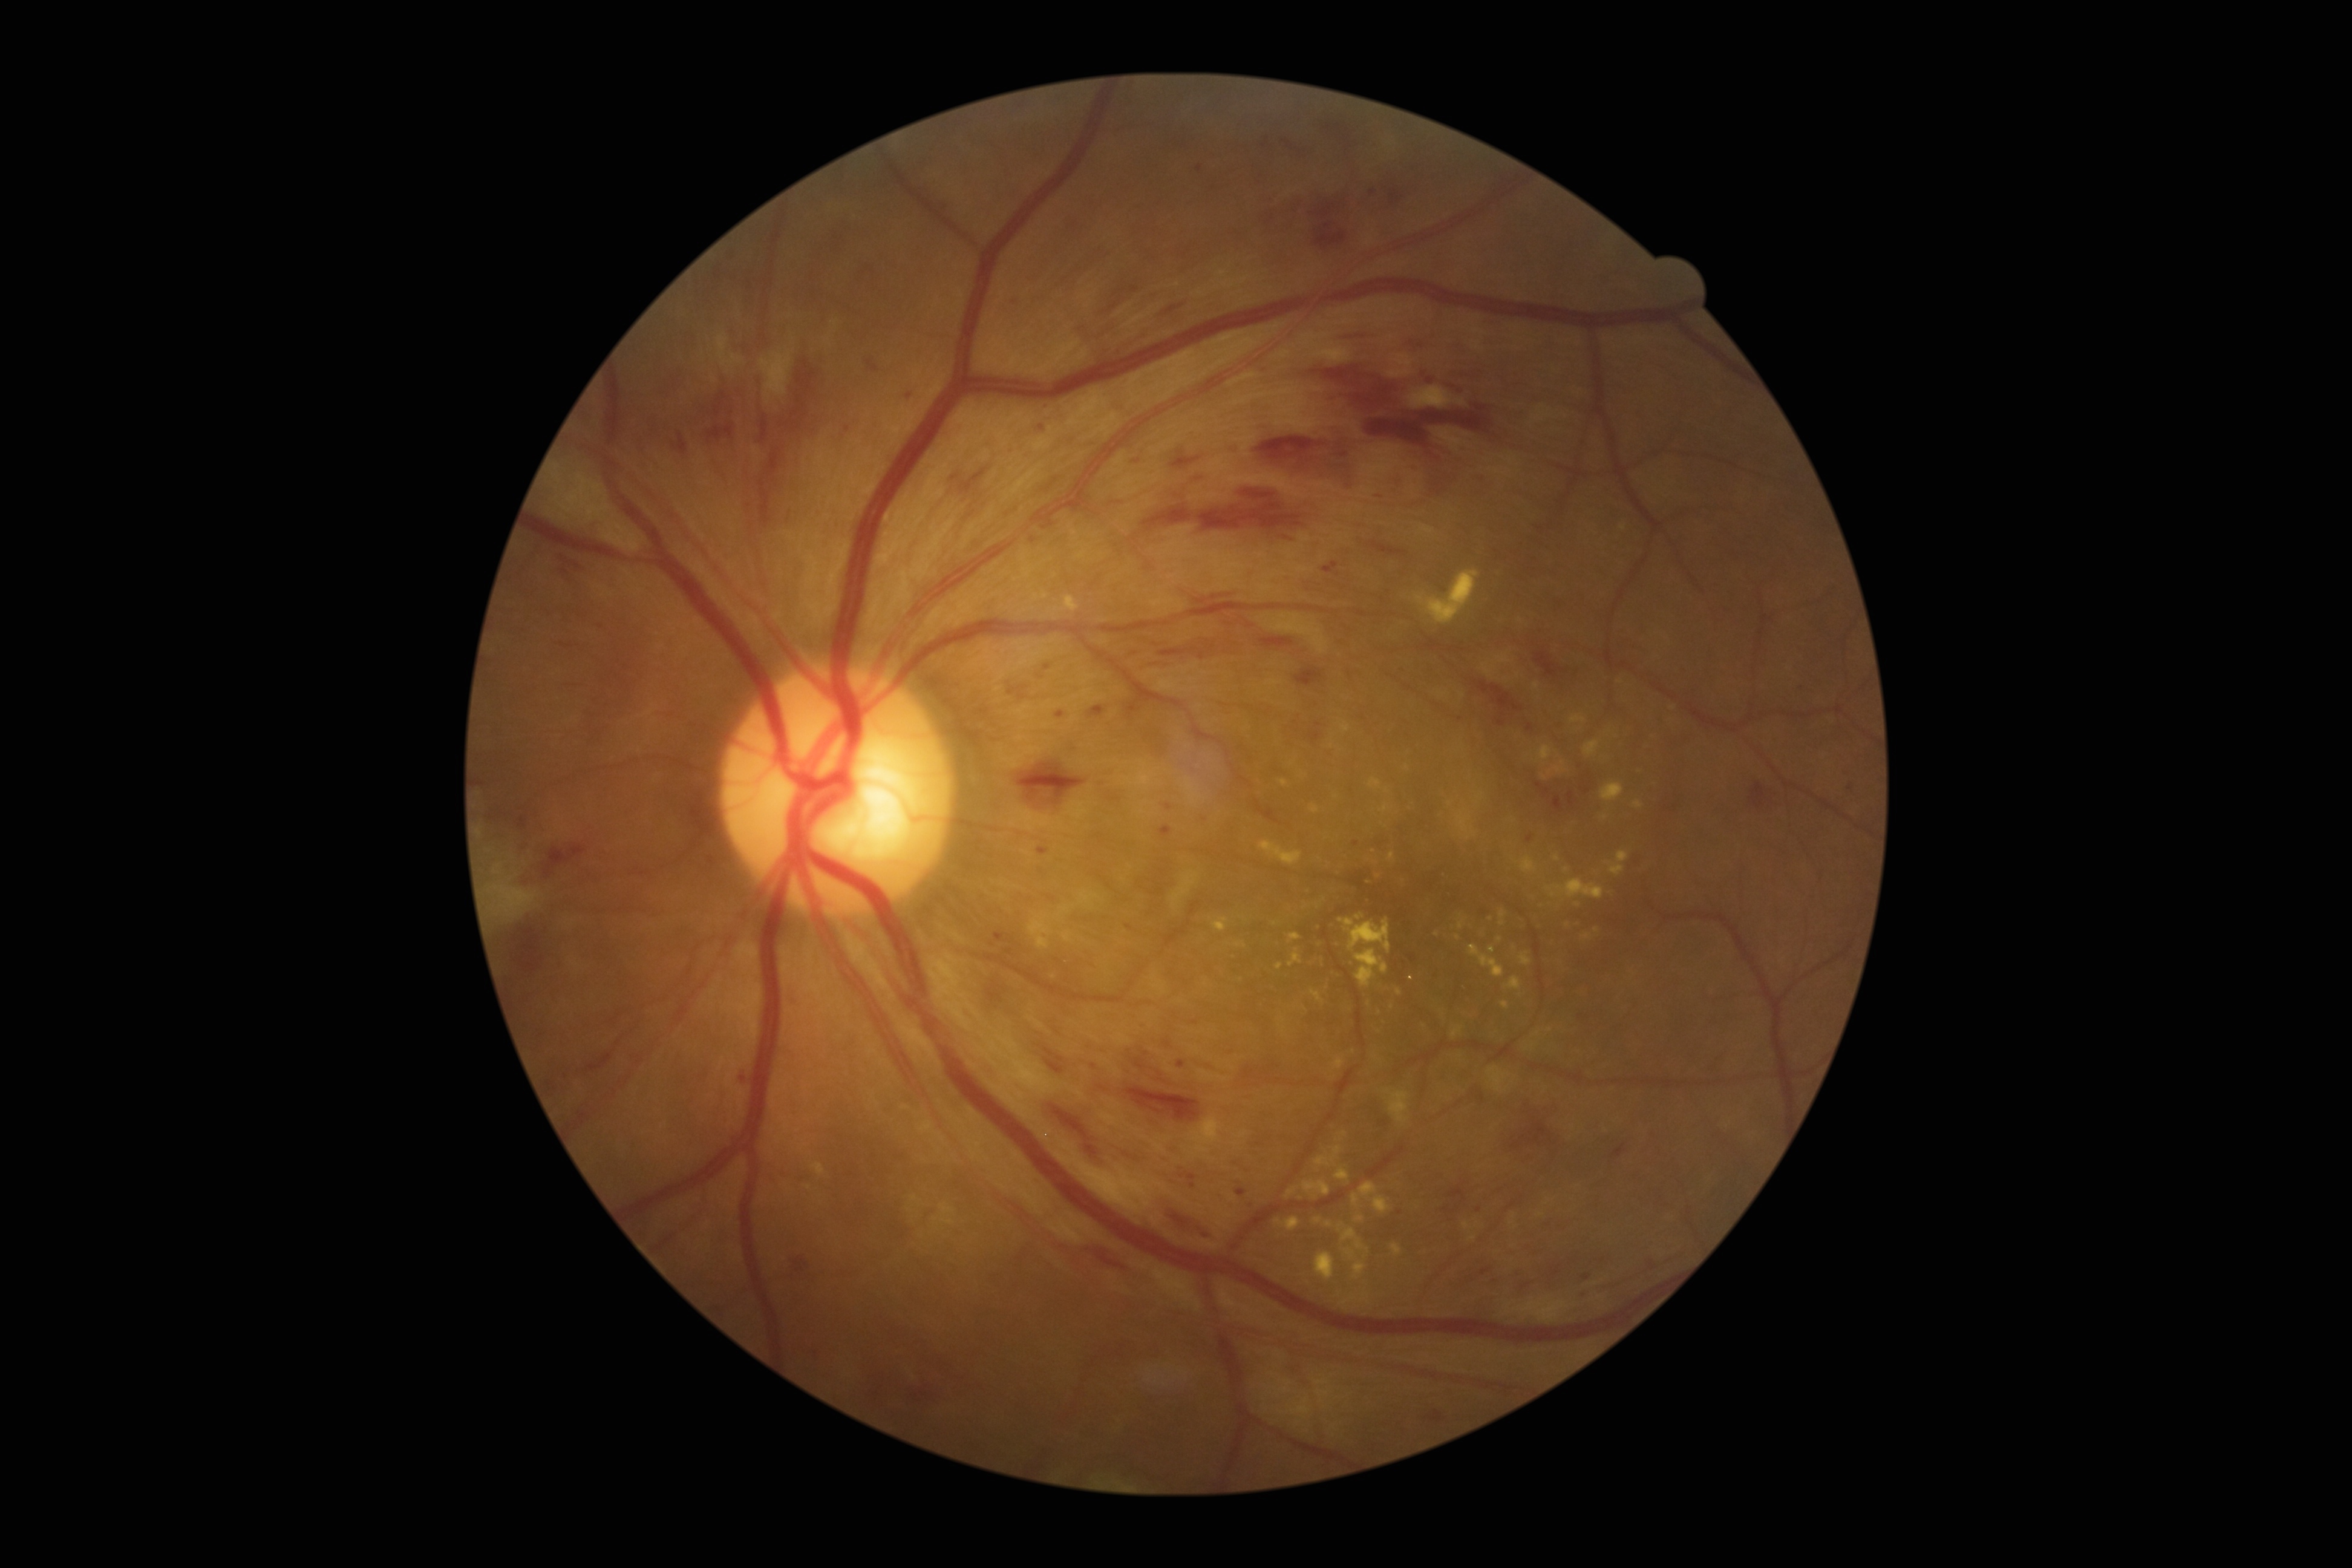

Diabetic retinopathy (DR) is grade 2 (moderate NPDR). Disease class: non-proliferative diabetic retinopathy.